130° field of view (Clarity RetCam 3). RetCam wide-field infant fundus image — 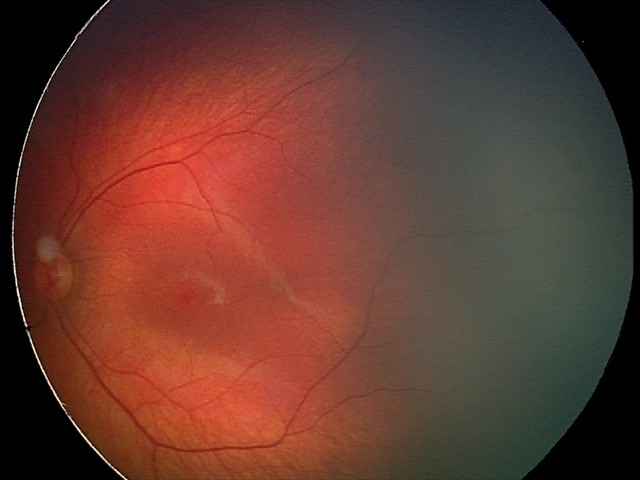

Screening series with retinal hemorrhages.